Nonmydriatic fundus photograph · graded on the modified Davis scale · 45° FOV
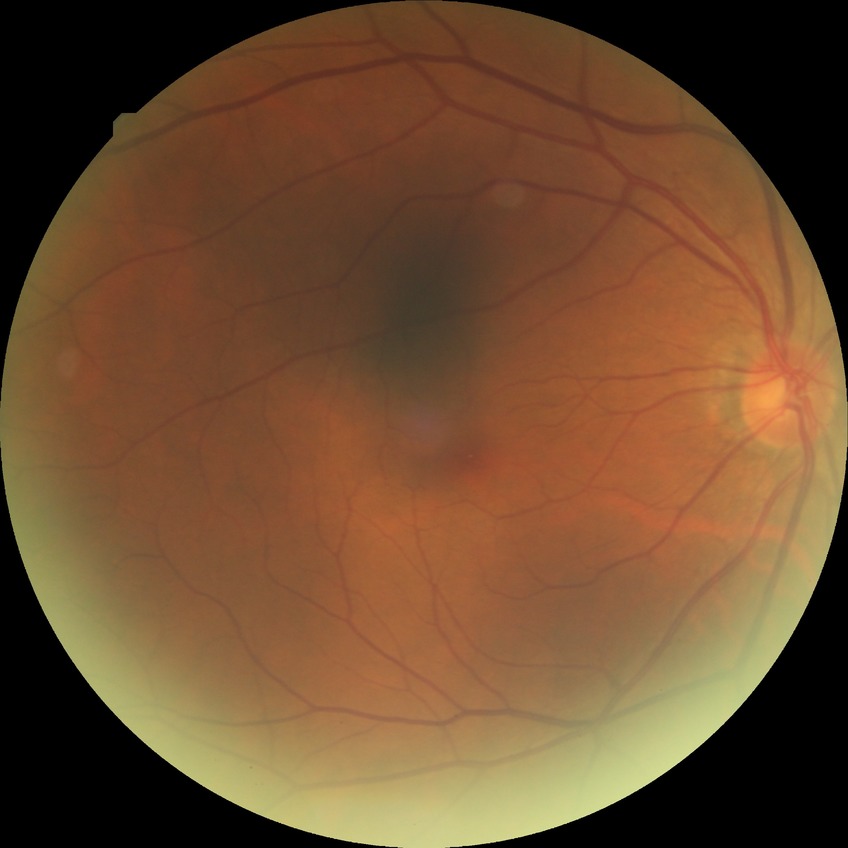 Diabetic retinopathy (DR): NDR (no diabetic retinopathy).